Pediatric wide-field fundus photograph — 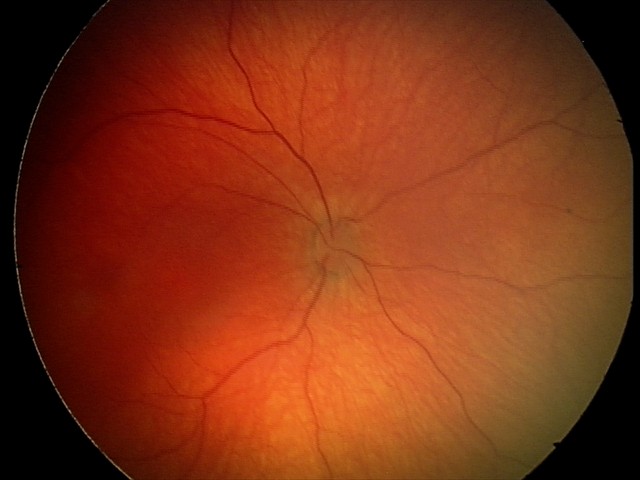
Screening examination with no abnormal retinal findings.